45° FOV: 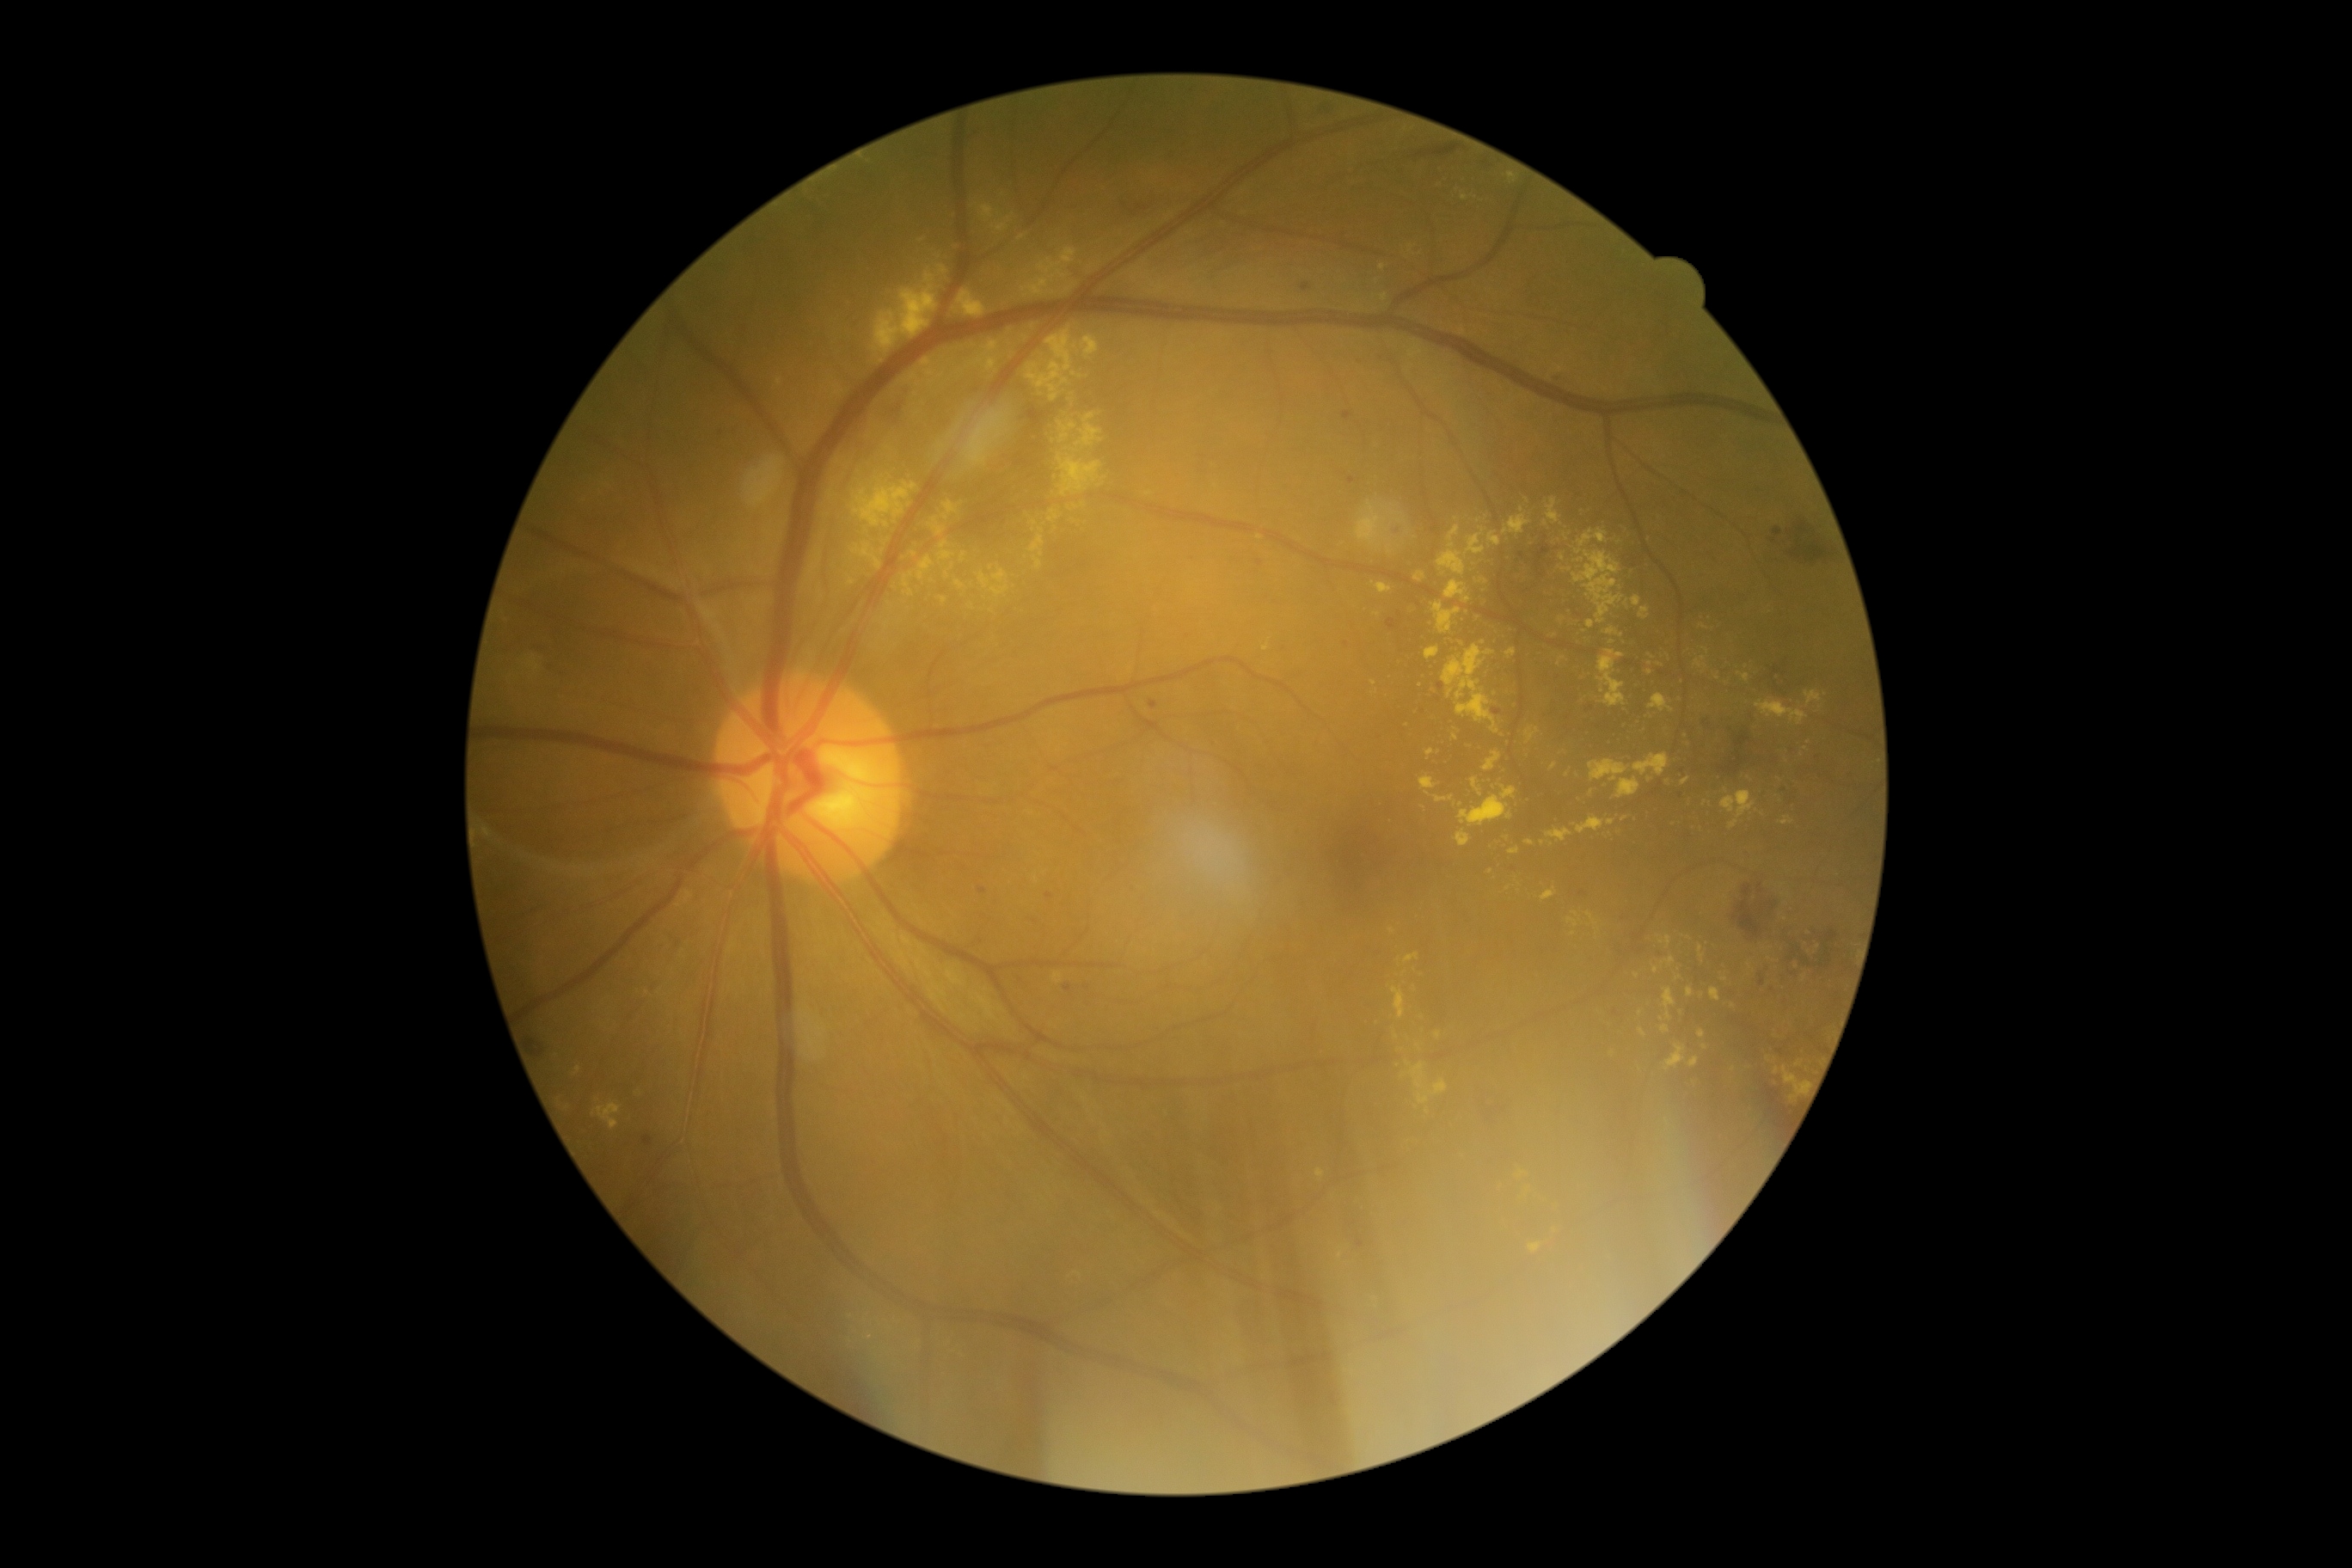

Retinopathy grade is 2/4 — more than just microaneurysms but less than severe NPDR
Lesions identified (partial list):
hard exudates (more not shown): (828,489,835,499), (1048,510,1060,524), (1756,701,1808,725), (1392,986,1406,1019), (1414,572,1426,582), (1471,778,1483,797), (1634,754,1669,776), (929,517,946,536), (847,575,855,587), (1574,529,1624,623), (1639,1029,1646,1038)
Additional small hard exudates near [914,555], [1522,1174], [1612,642], [1734,1006], [922,241], [1650,778], [1035,523], [1460,805], [1562,619]